Camera: Clarity RetCam 3 (130° FOV). Wide-field fundus photograph from neonatal ROP screening
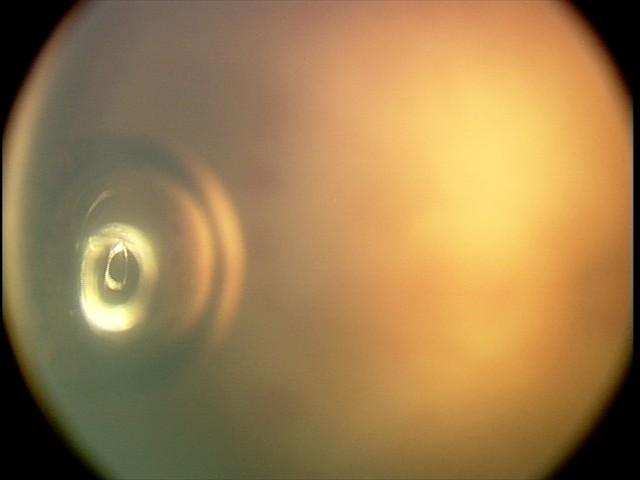

Assessment: plus disease | aggressive retinopathy of prematurity.